45° field of view · color fundus image · 1932 x 1932 pixels
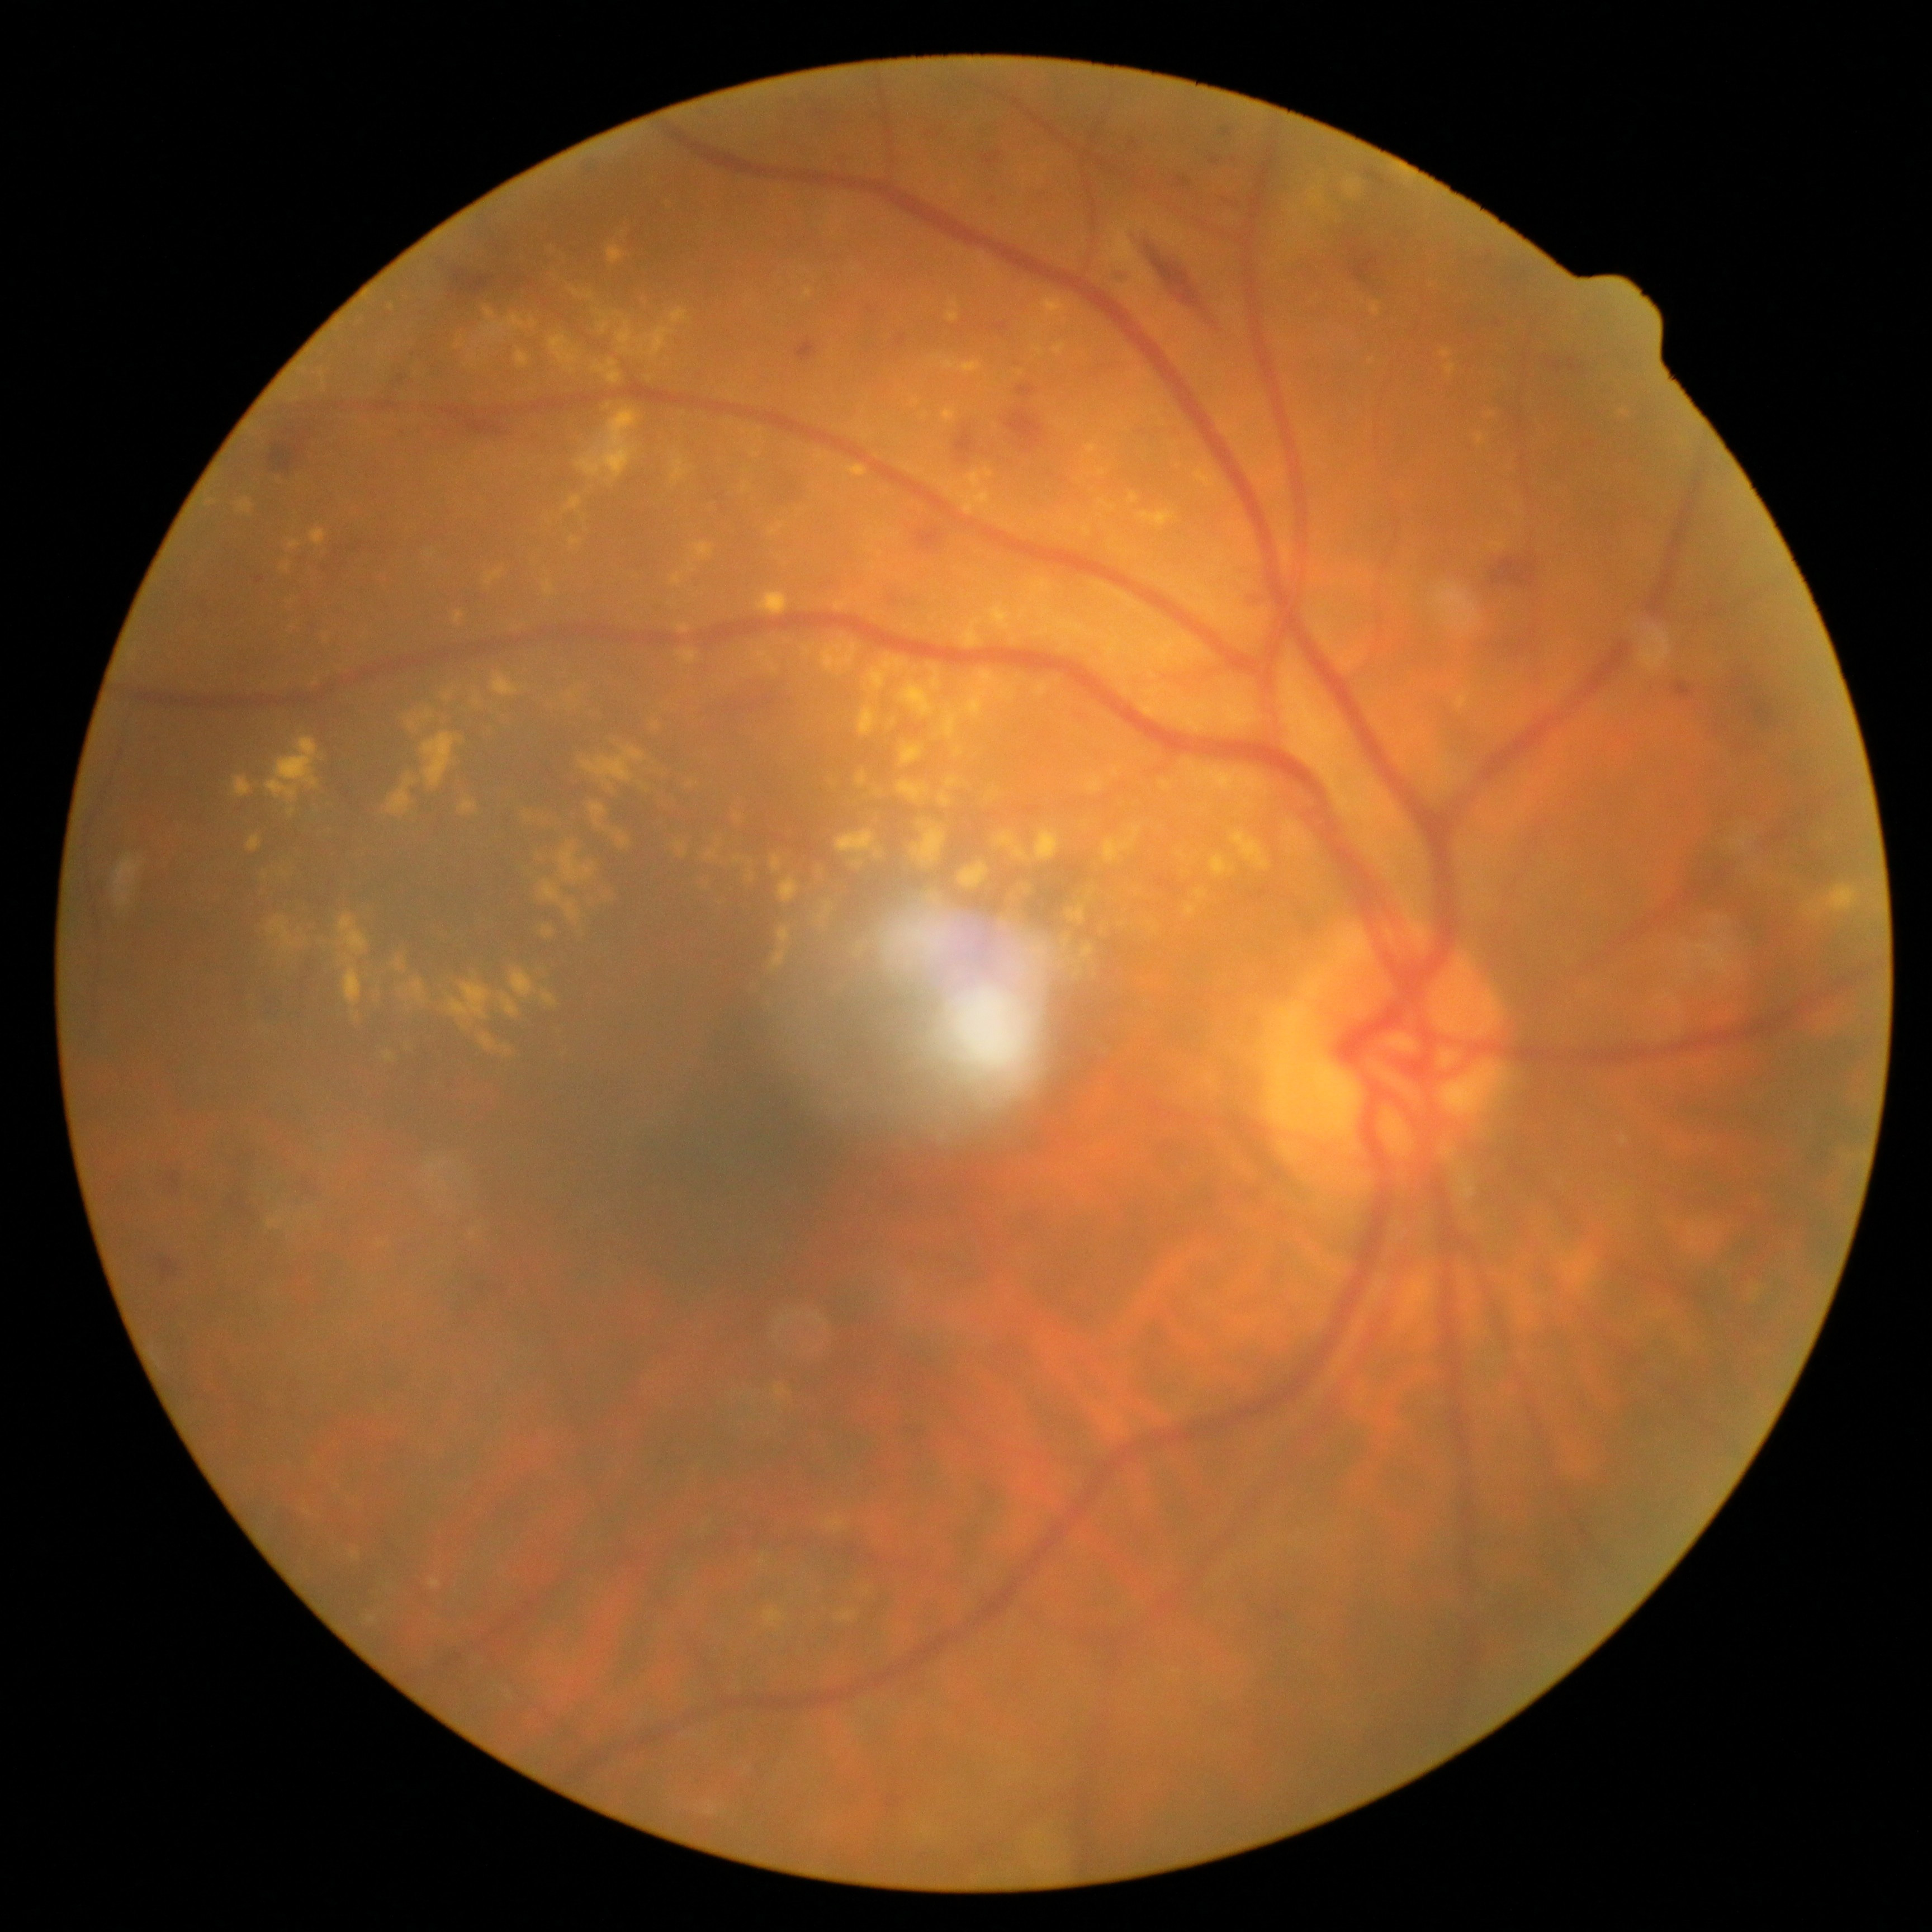
DR@moderate NPDR (grade 2).